Wide-field contact fundus photograph of an infant; 1240x1240; 100° field of view (Phoenix ICON):
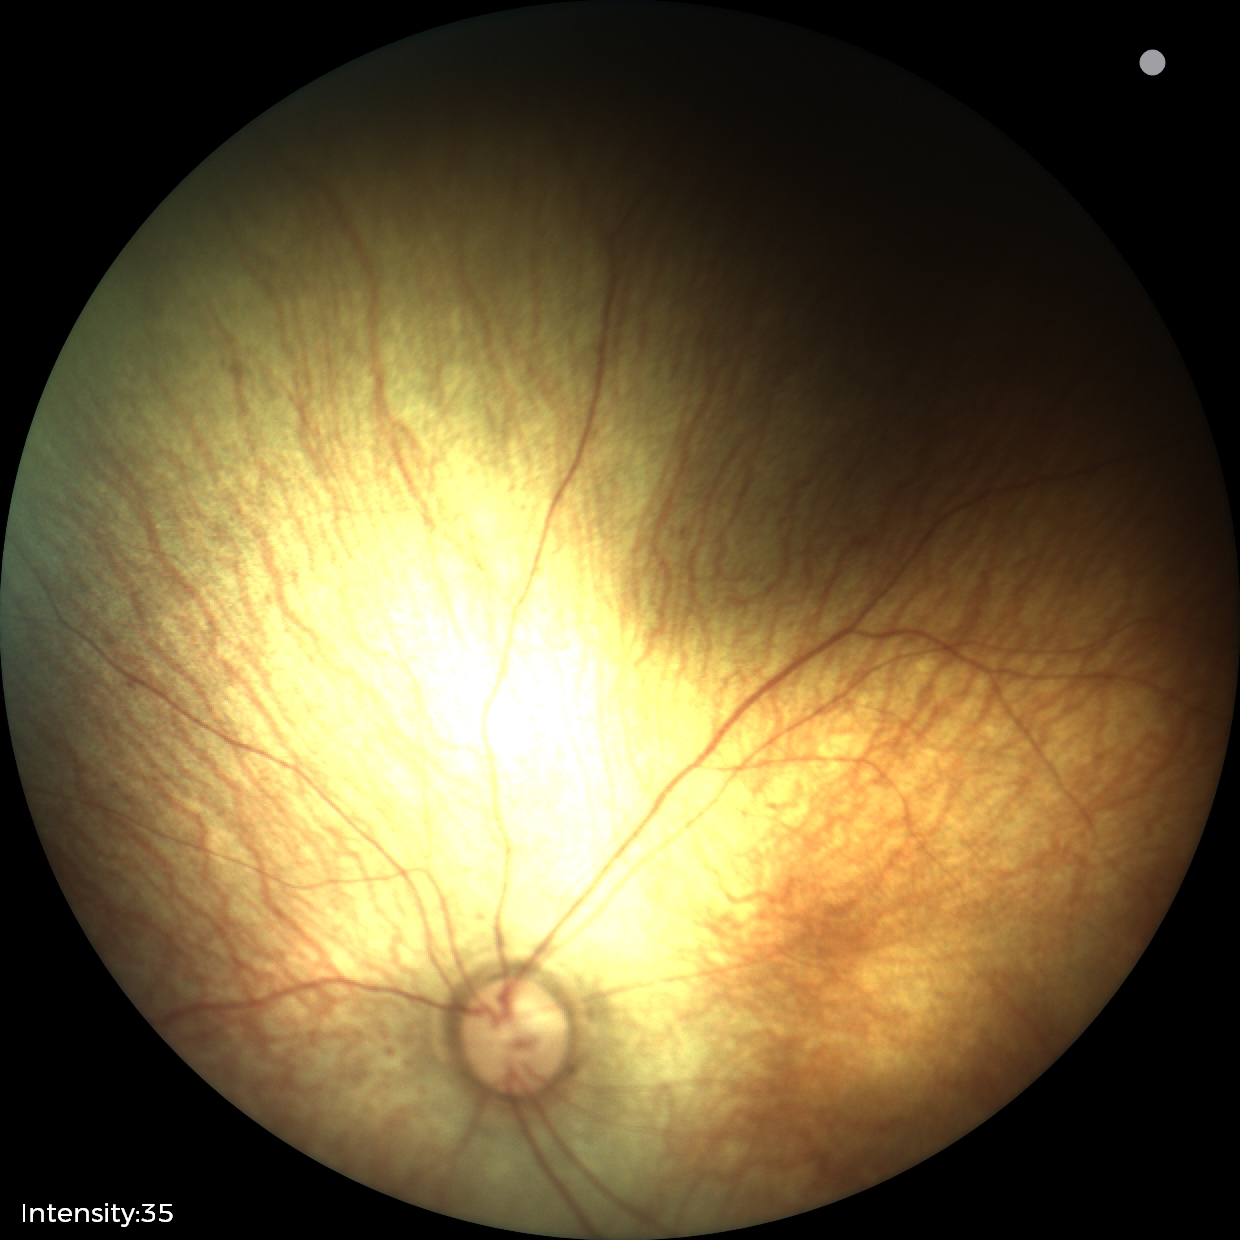
Screening examination diagnosed as physiological.